1240x1240px. Captured with the Phoenix ICON (100° field of view). Wide-field fundus photograph of an infant — 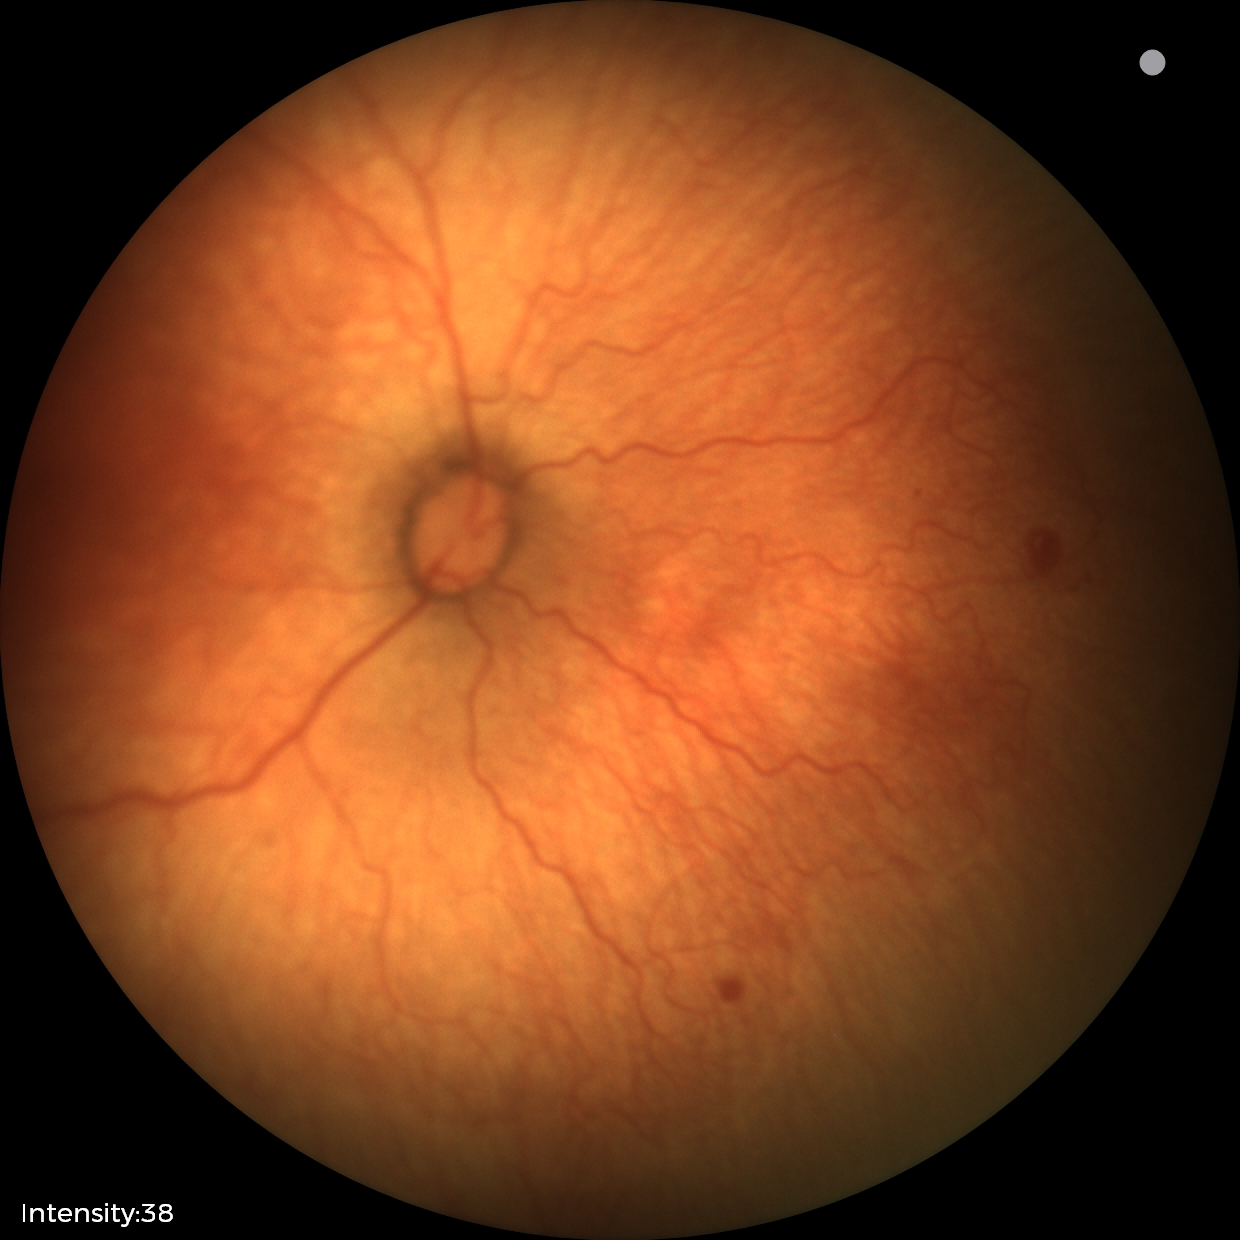
Diagnosis from this screening exam: retinopathy of prematurity stage 1.